Color fundus photograph; 45-degree field of view — 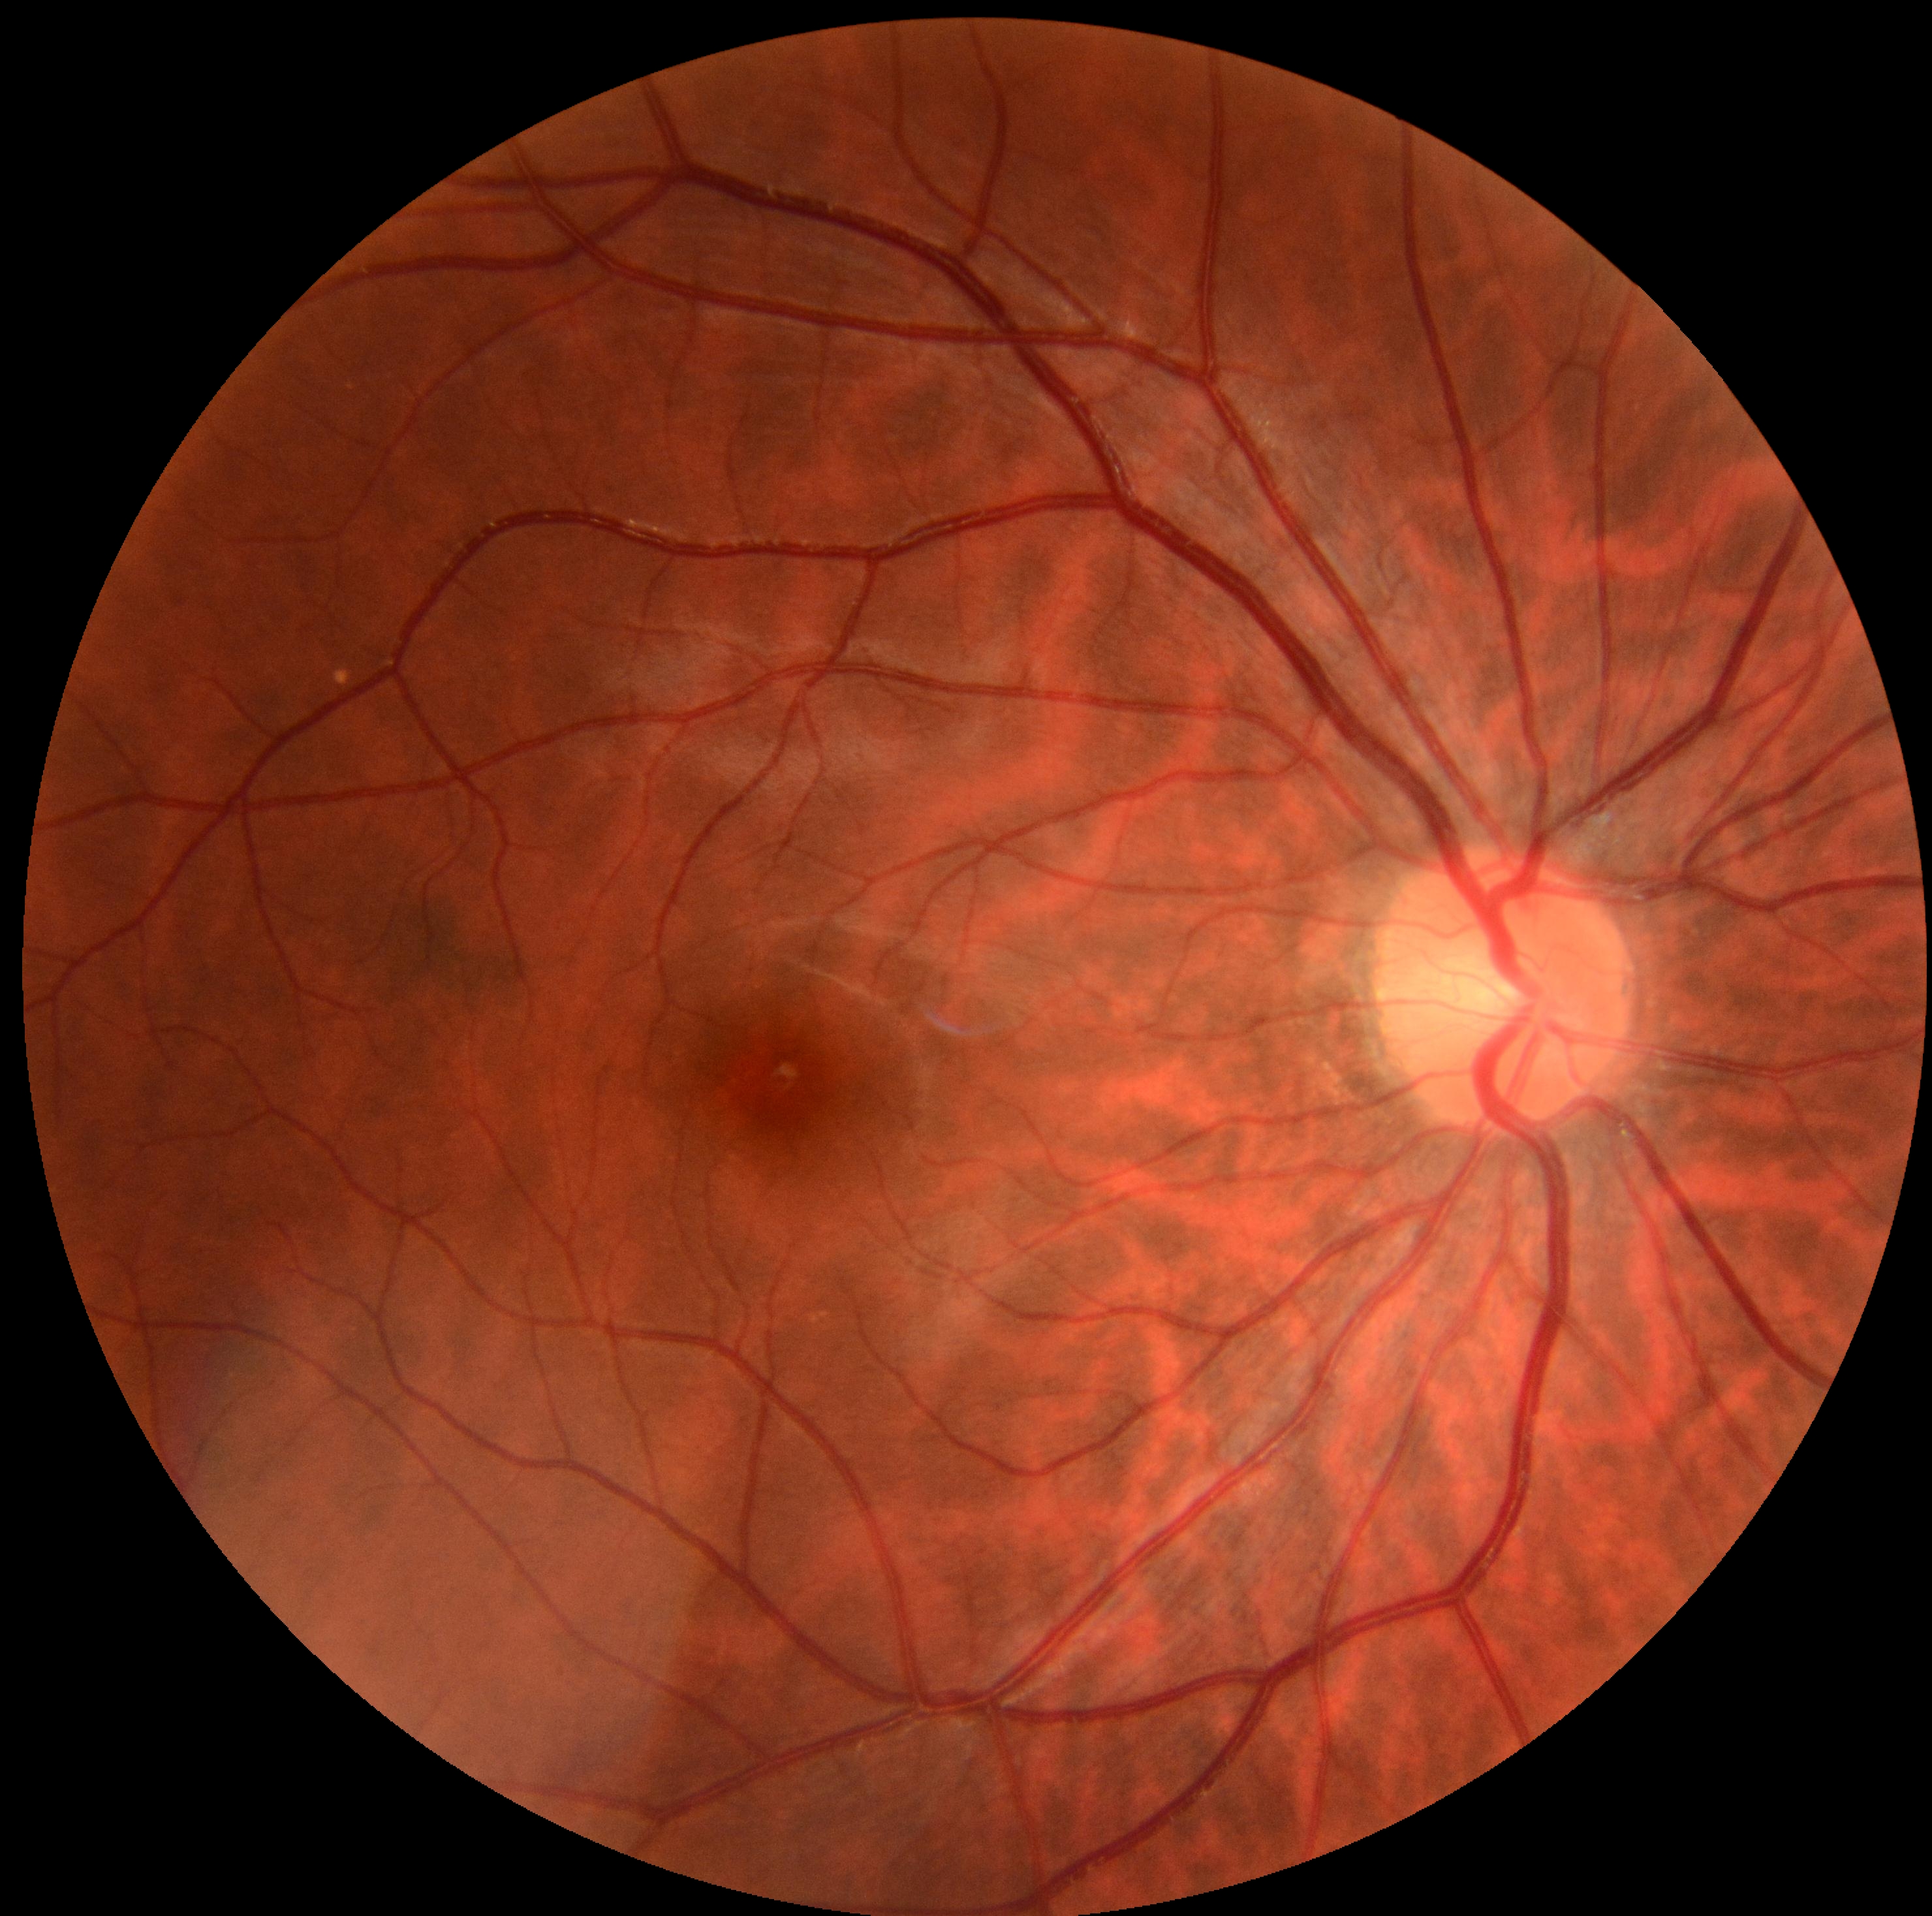

Diabetic retinopathy severity is no apparent retinopathy (grade 0).